Retinal fundus photograph, non-mydriatic
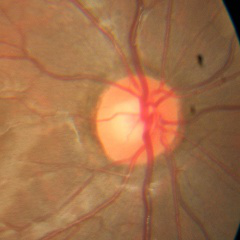

Glaucoma stage: no evidence of glaucoma.